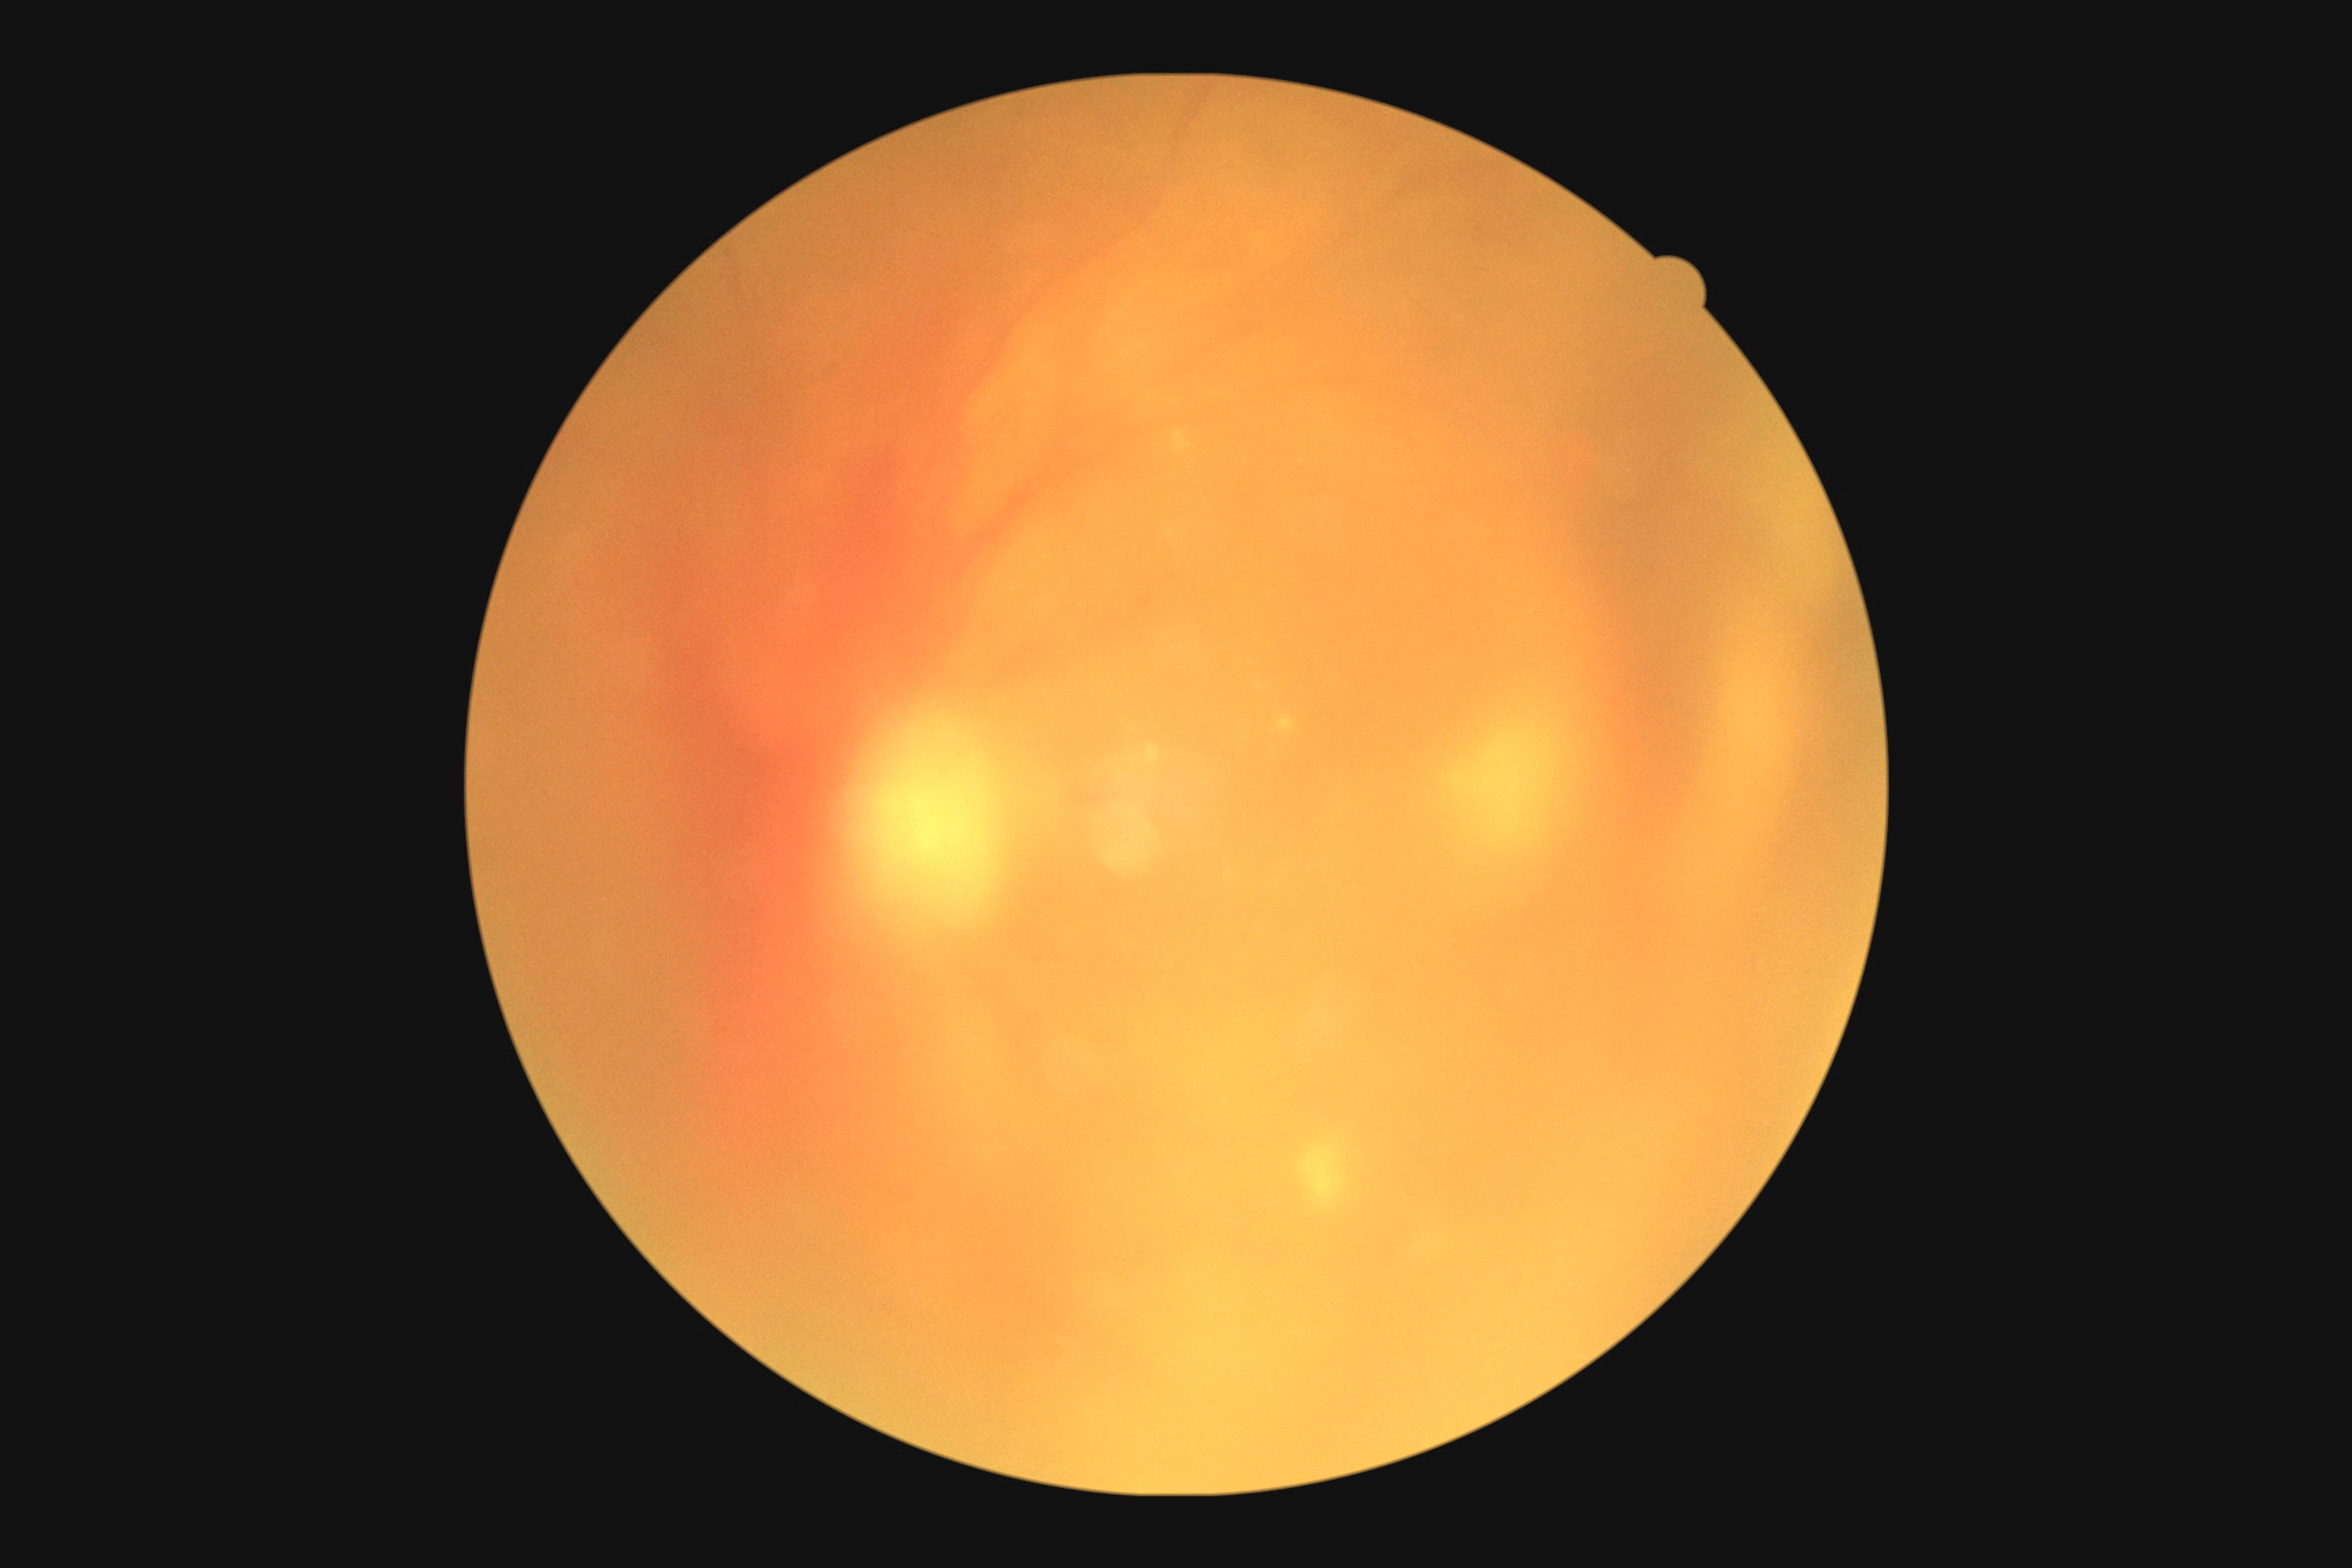 DR stage: 4.